45° field of view: 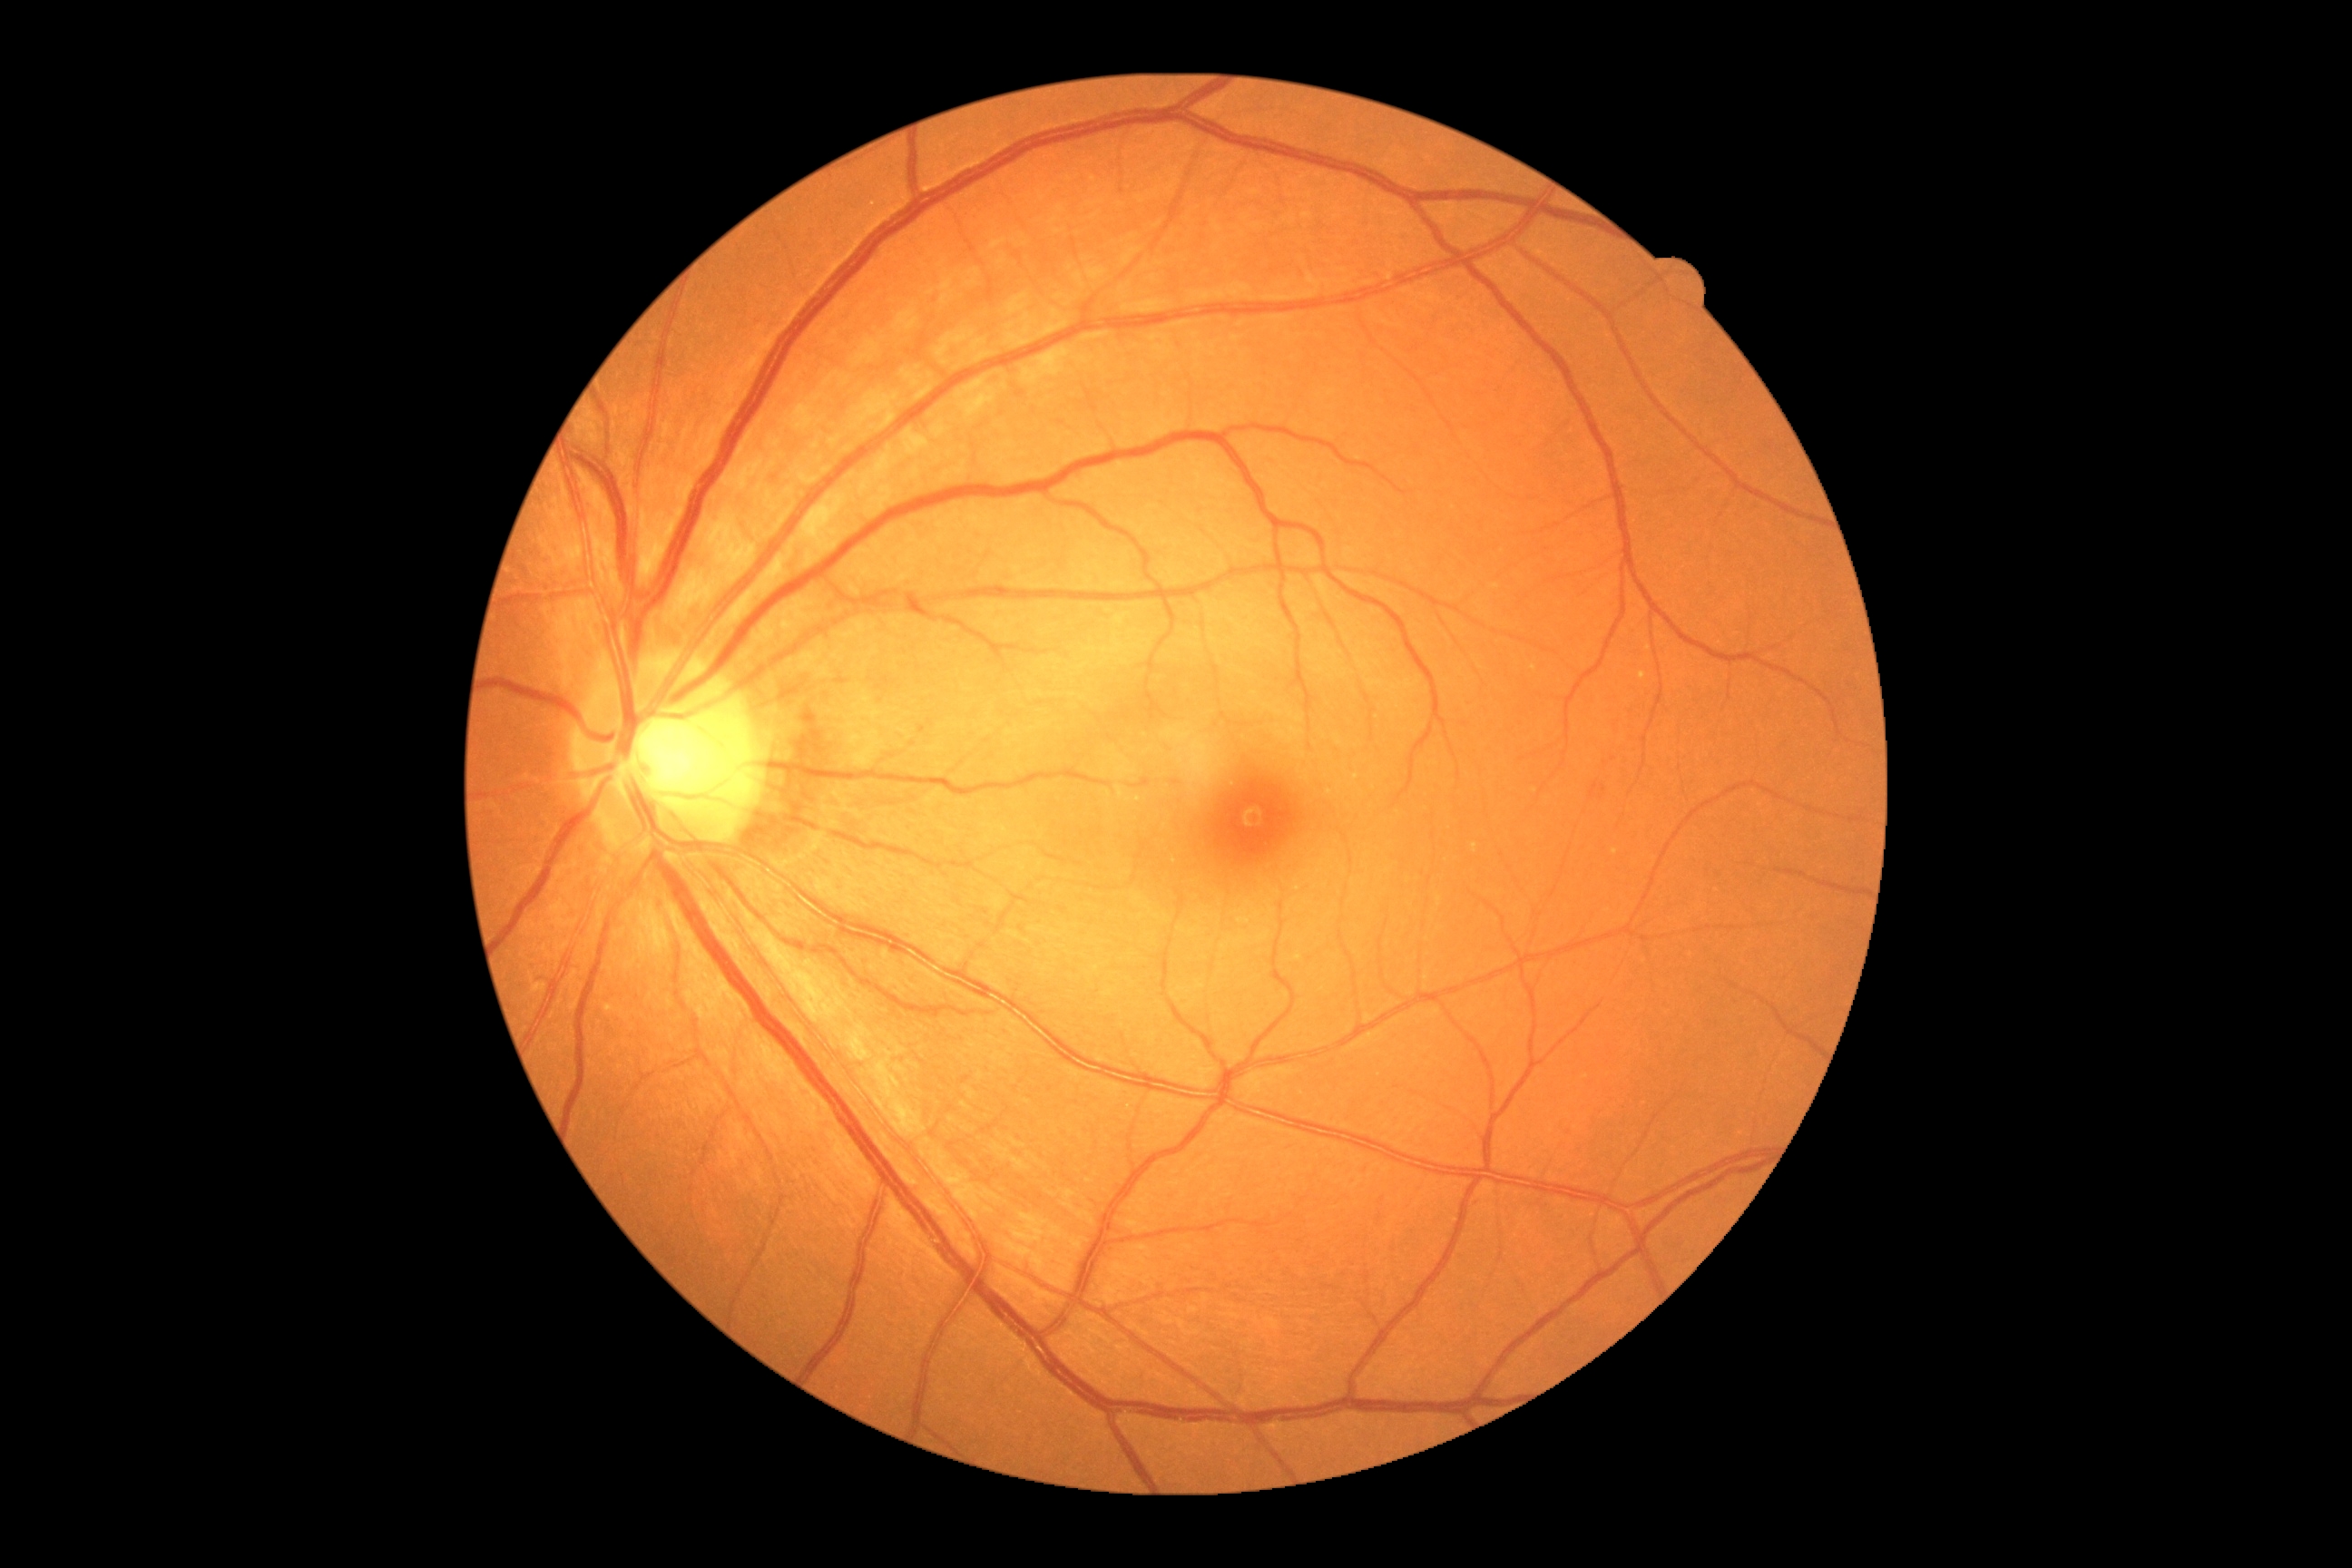 DR: grade 0, DR impression: no apparent DR.